CFP; no pharmacologic dilation: 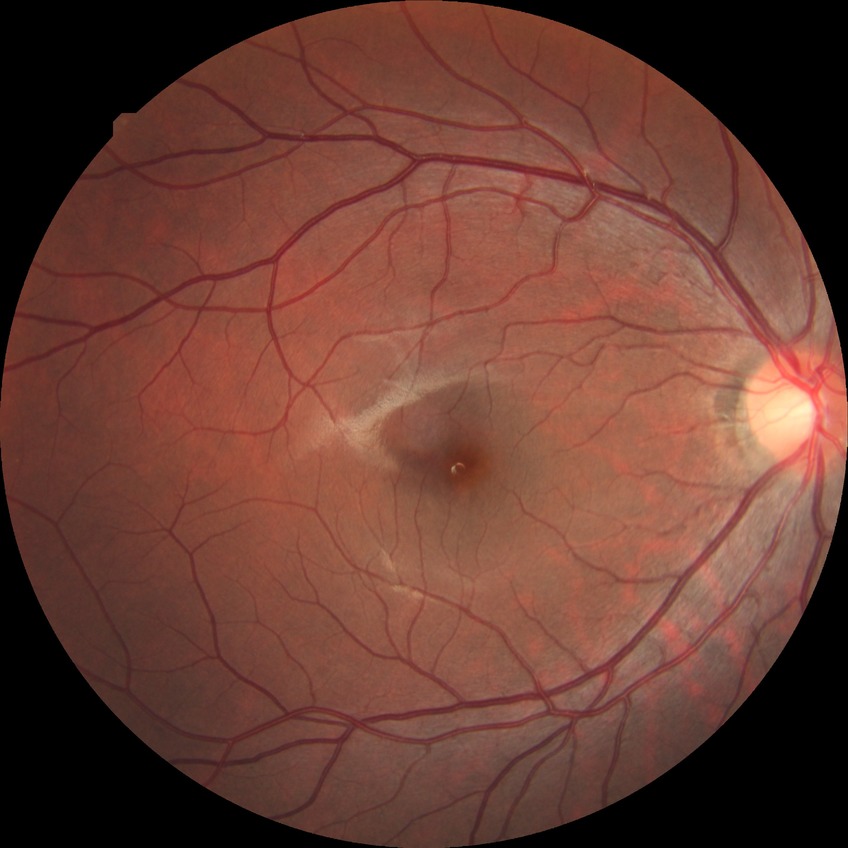 DR stage: NDR.